50° FOV. Mydriatic (tropicamide and phenylephrine). 2228 x 1652 pixels. Topcon TRC-50DX. Field includes the optic disc and macula
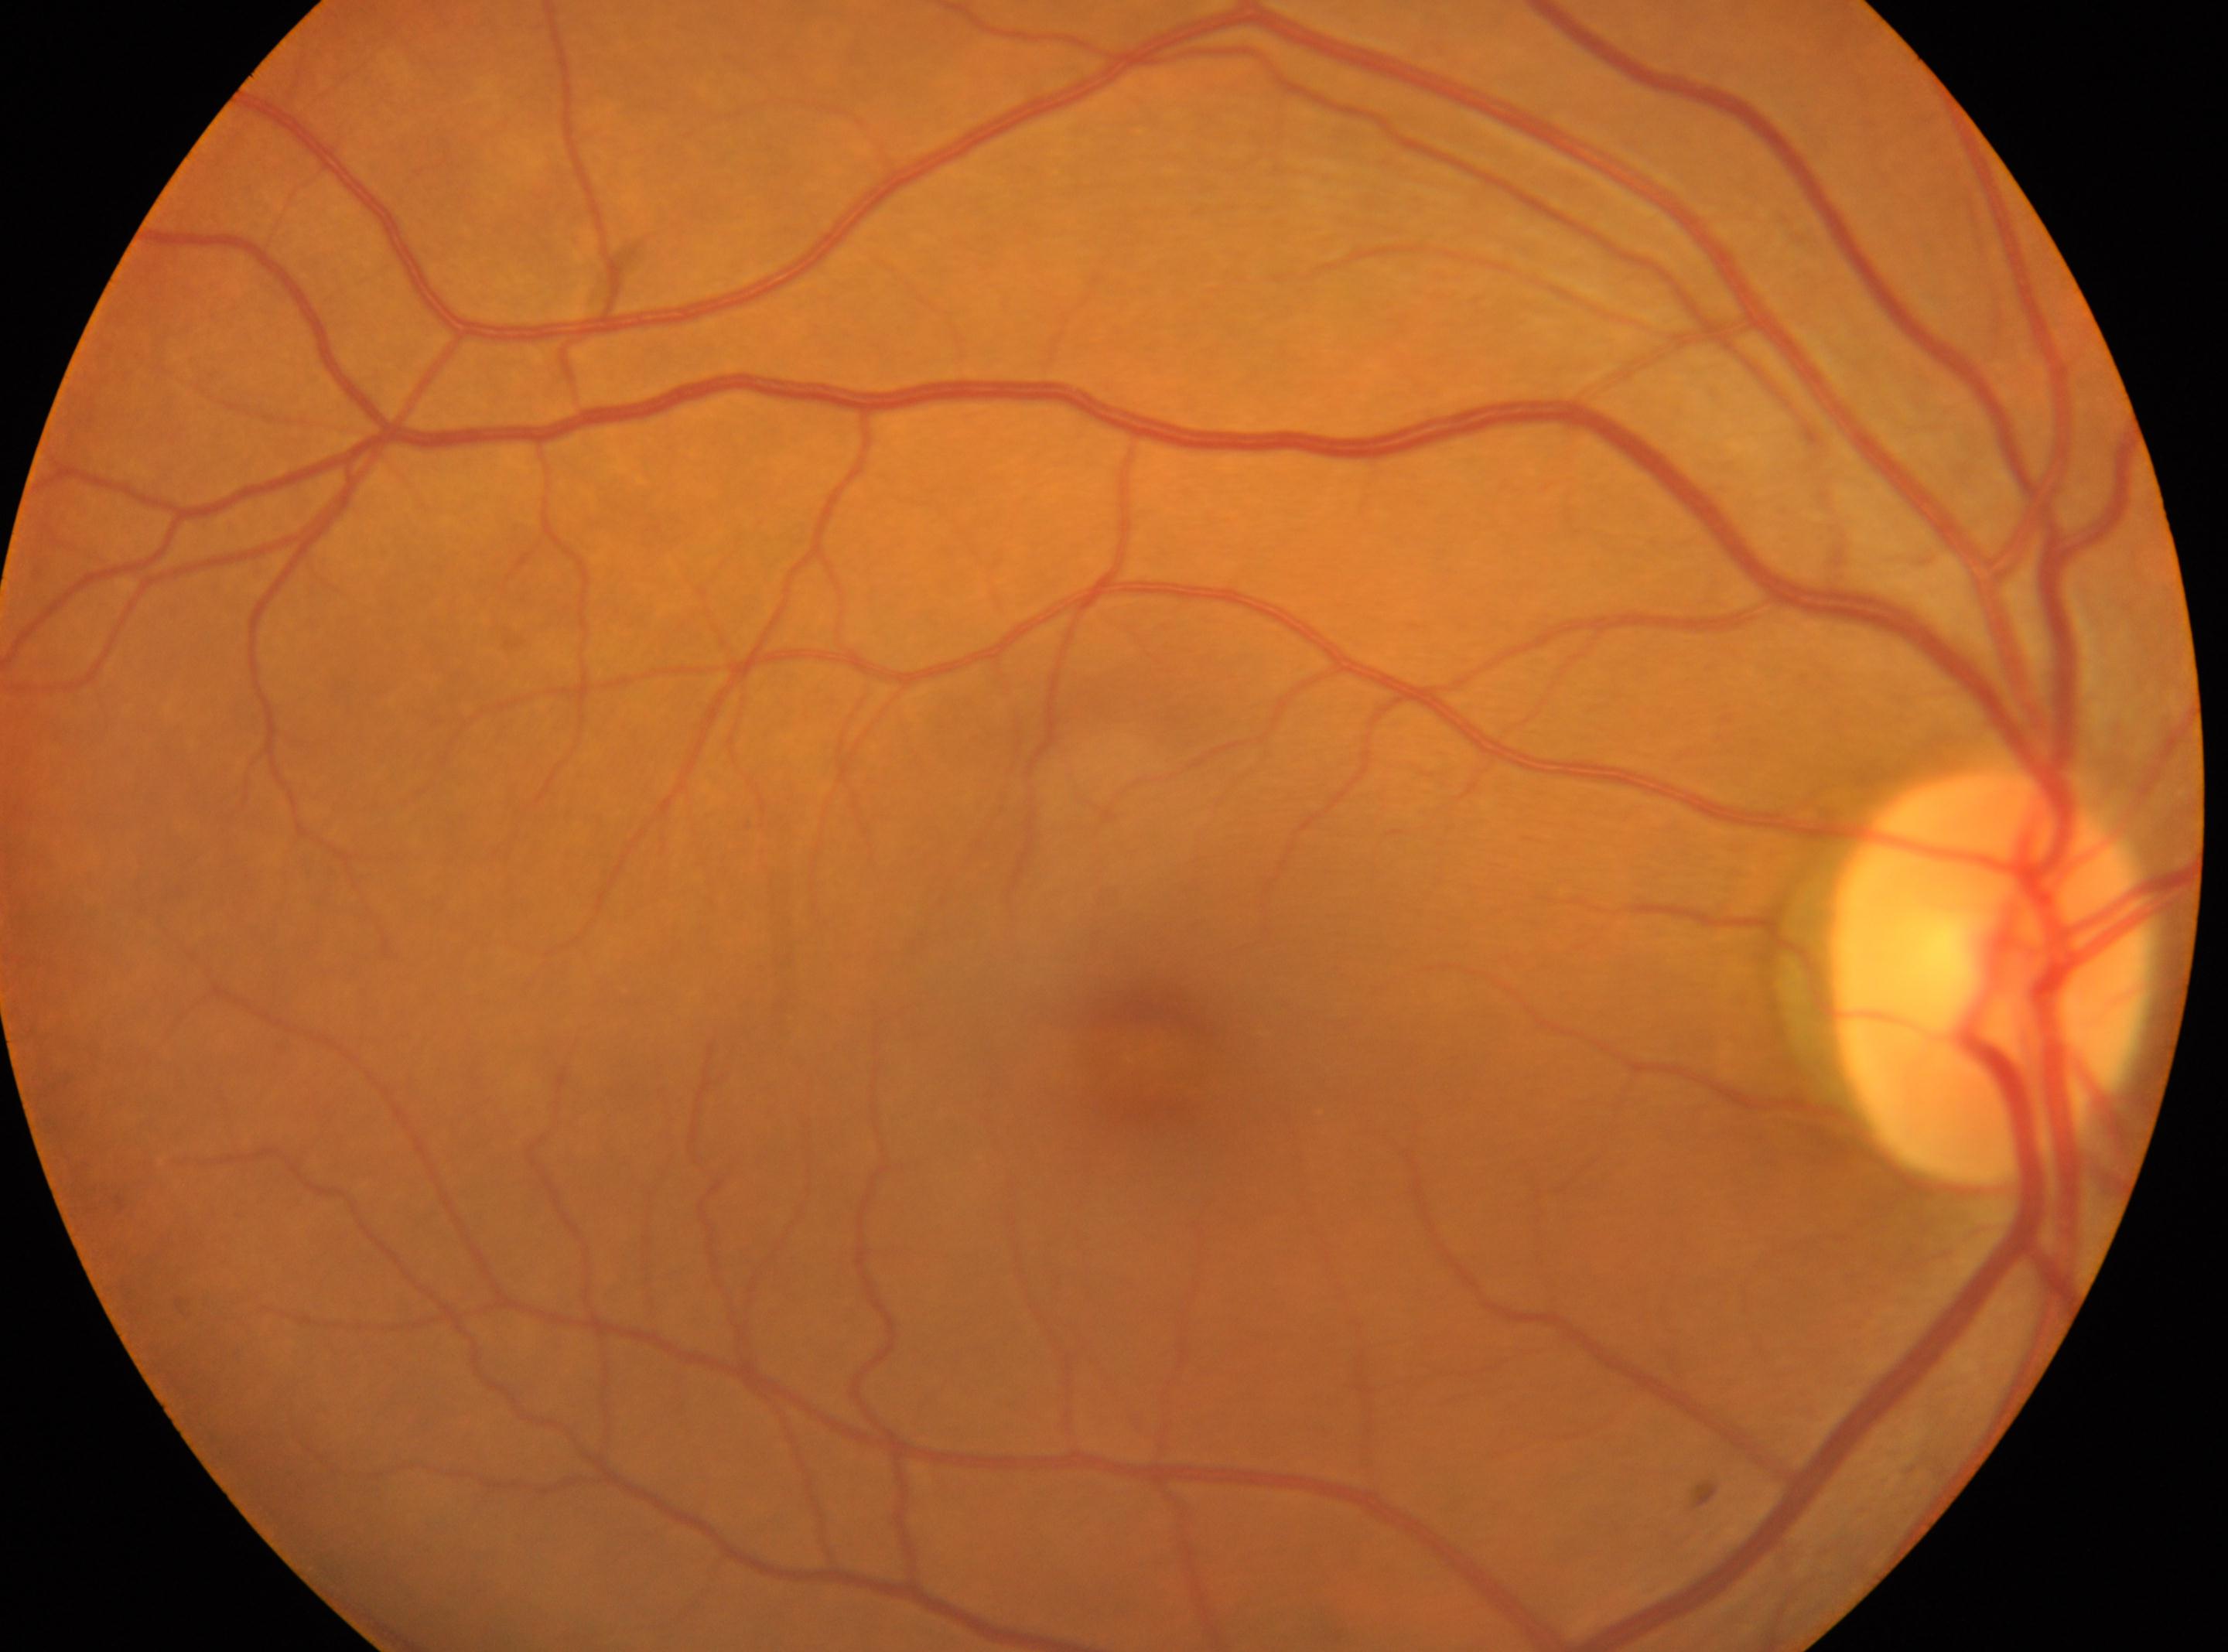

| field | value |
|---|---|
| optic disk | (x: 1992, y: 974) |
| foveal center | (x: 1150, y: 1050) |
| eye | OD |
| DR grade | 0 (no apparent retinopathy) |
| DR impression | No DR findings |